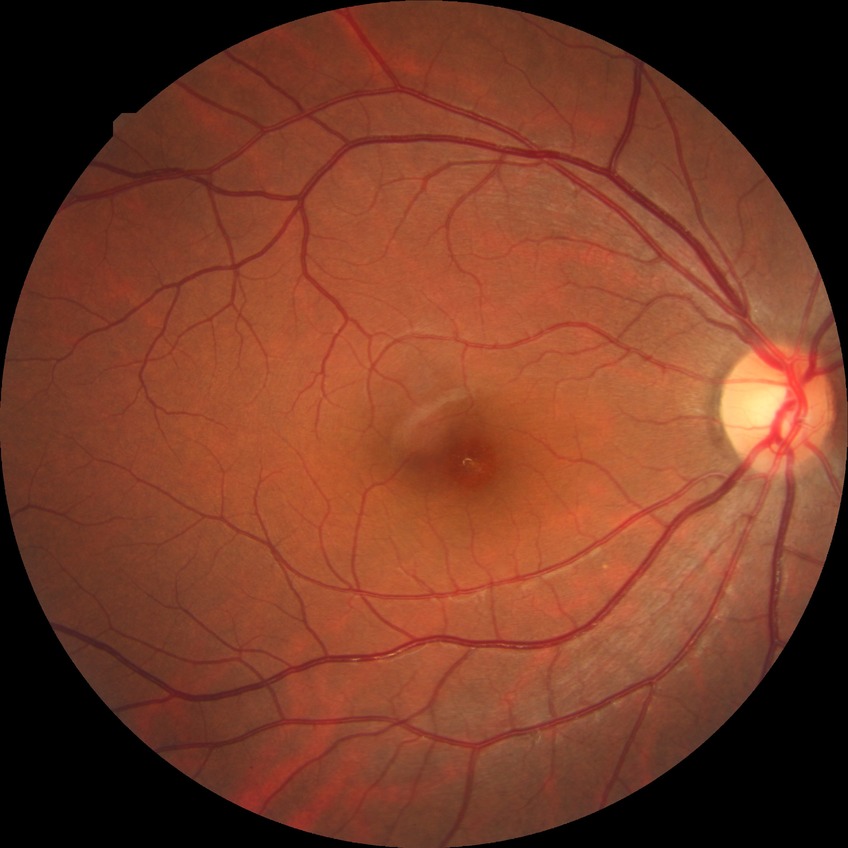
Diabetic retinopathy (DR): no diabetic retinopathy (NDR).